45-degree field of view; NIDEK AFC-230; 848x848px: 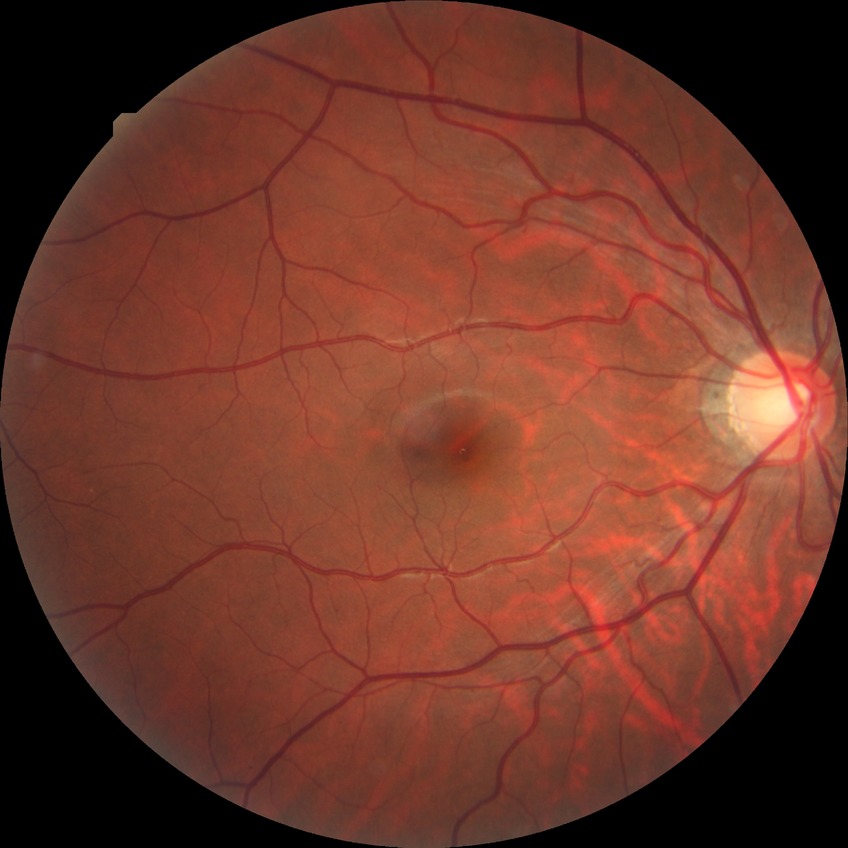

diabetic retinopathy stage@no diabetic retinopathy.